DR severity per modified Davis staging; nonmydriatic fundus photograph
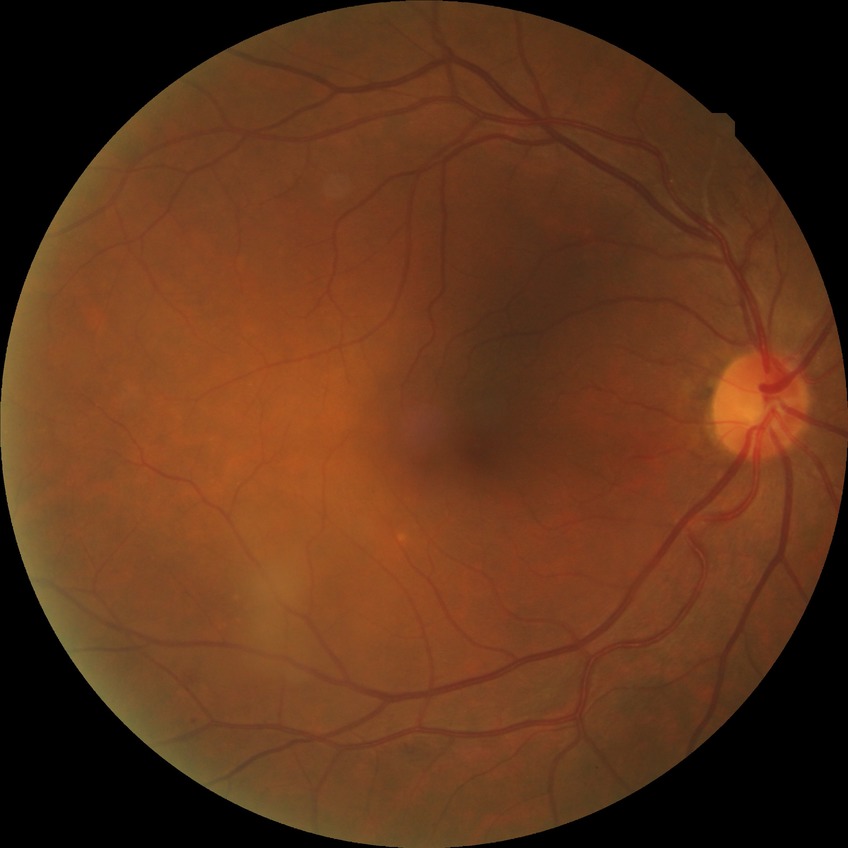
DR class: non-proliferative diabetic retinopathy.
Diabetic retinopathy (DR) is SDR (simple diabetic retinopathy).